Without pupil dilation · NIDEK AFC-230.
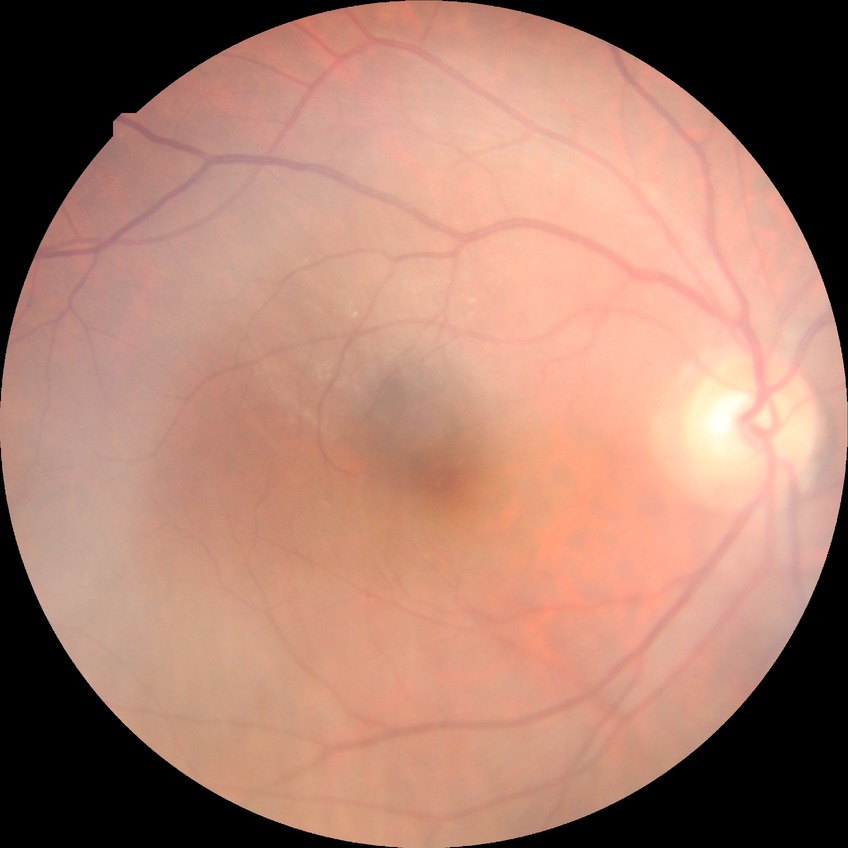
Modified Davis classification: simple diabetic retinopathy.